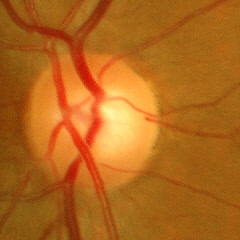
Glaucoma diagnosis: no evidence of glaucoma.